Without pupil dilation · acquired with a NIDEK AFC-230.
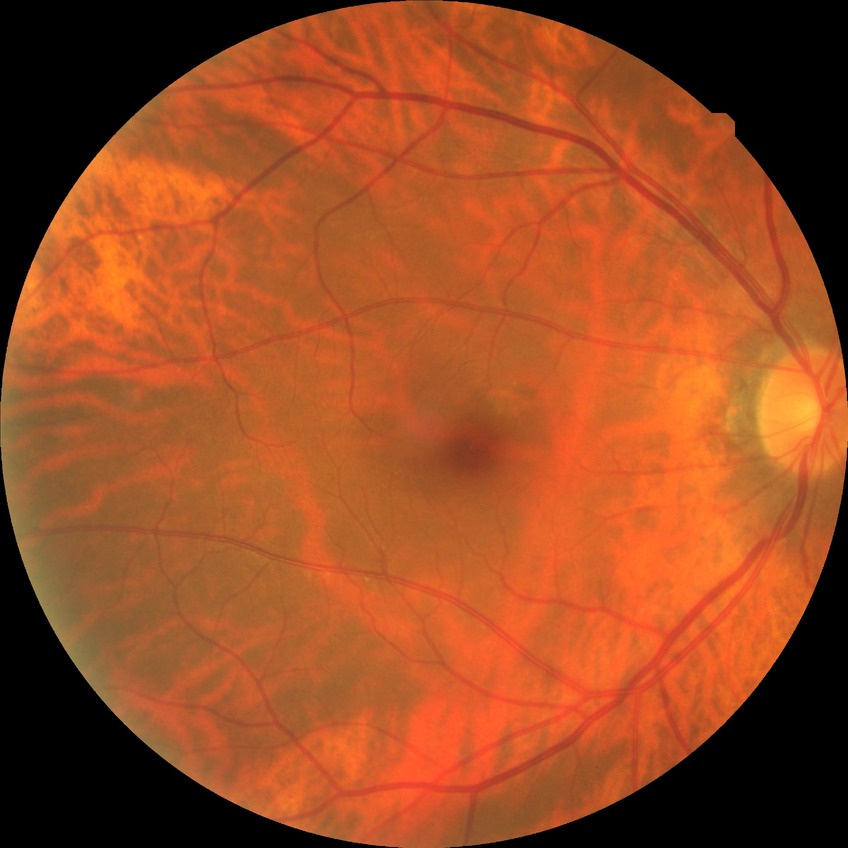

• diabetic retinopathy severity: no diabetic retinopathy